240x240, color fundus image.
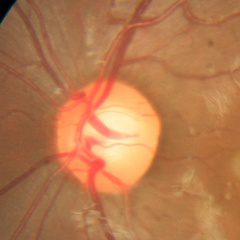
Q: Glaucoma assessment?
A: No glaucoma.